Modified Davis grading:
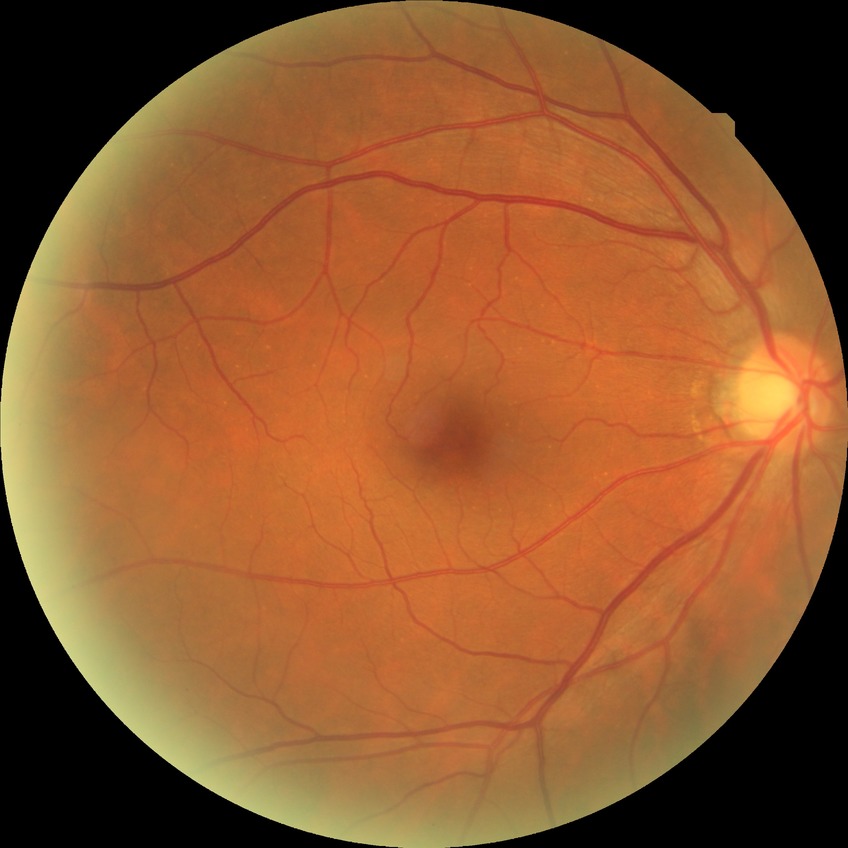

Findings:
– diabetic retinopathy grade — no diabetic retinopathy